Pupil-dilated; 2228 x 1652 pixels; posterior pole view; fundus photo.
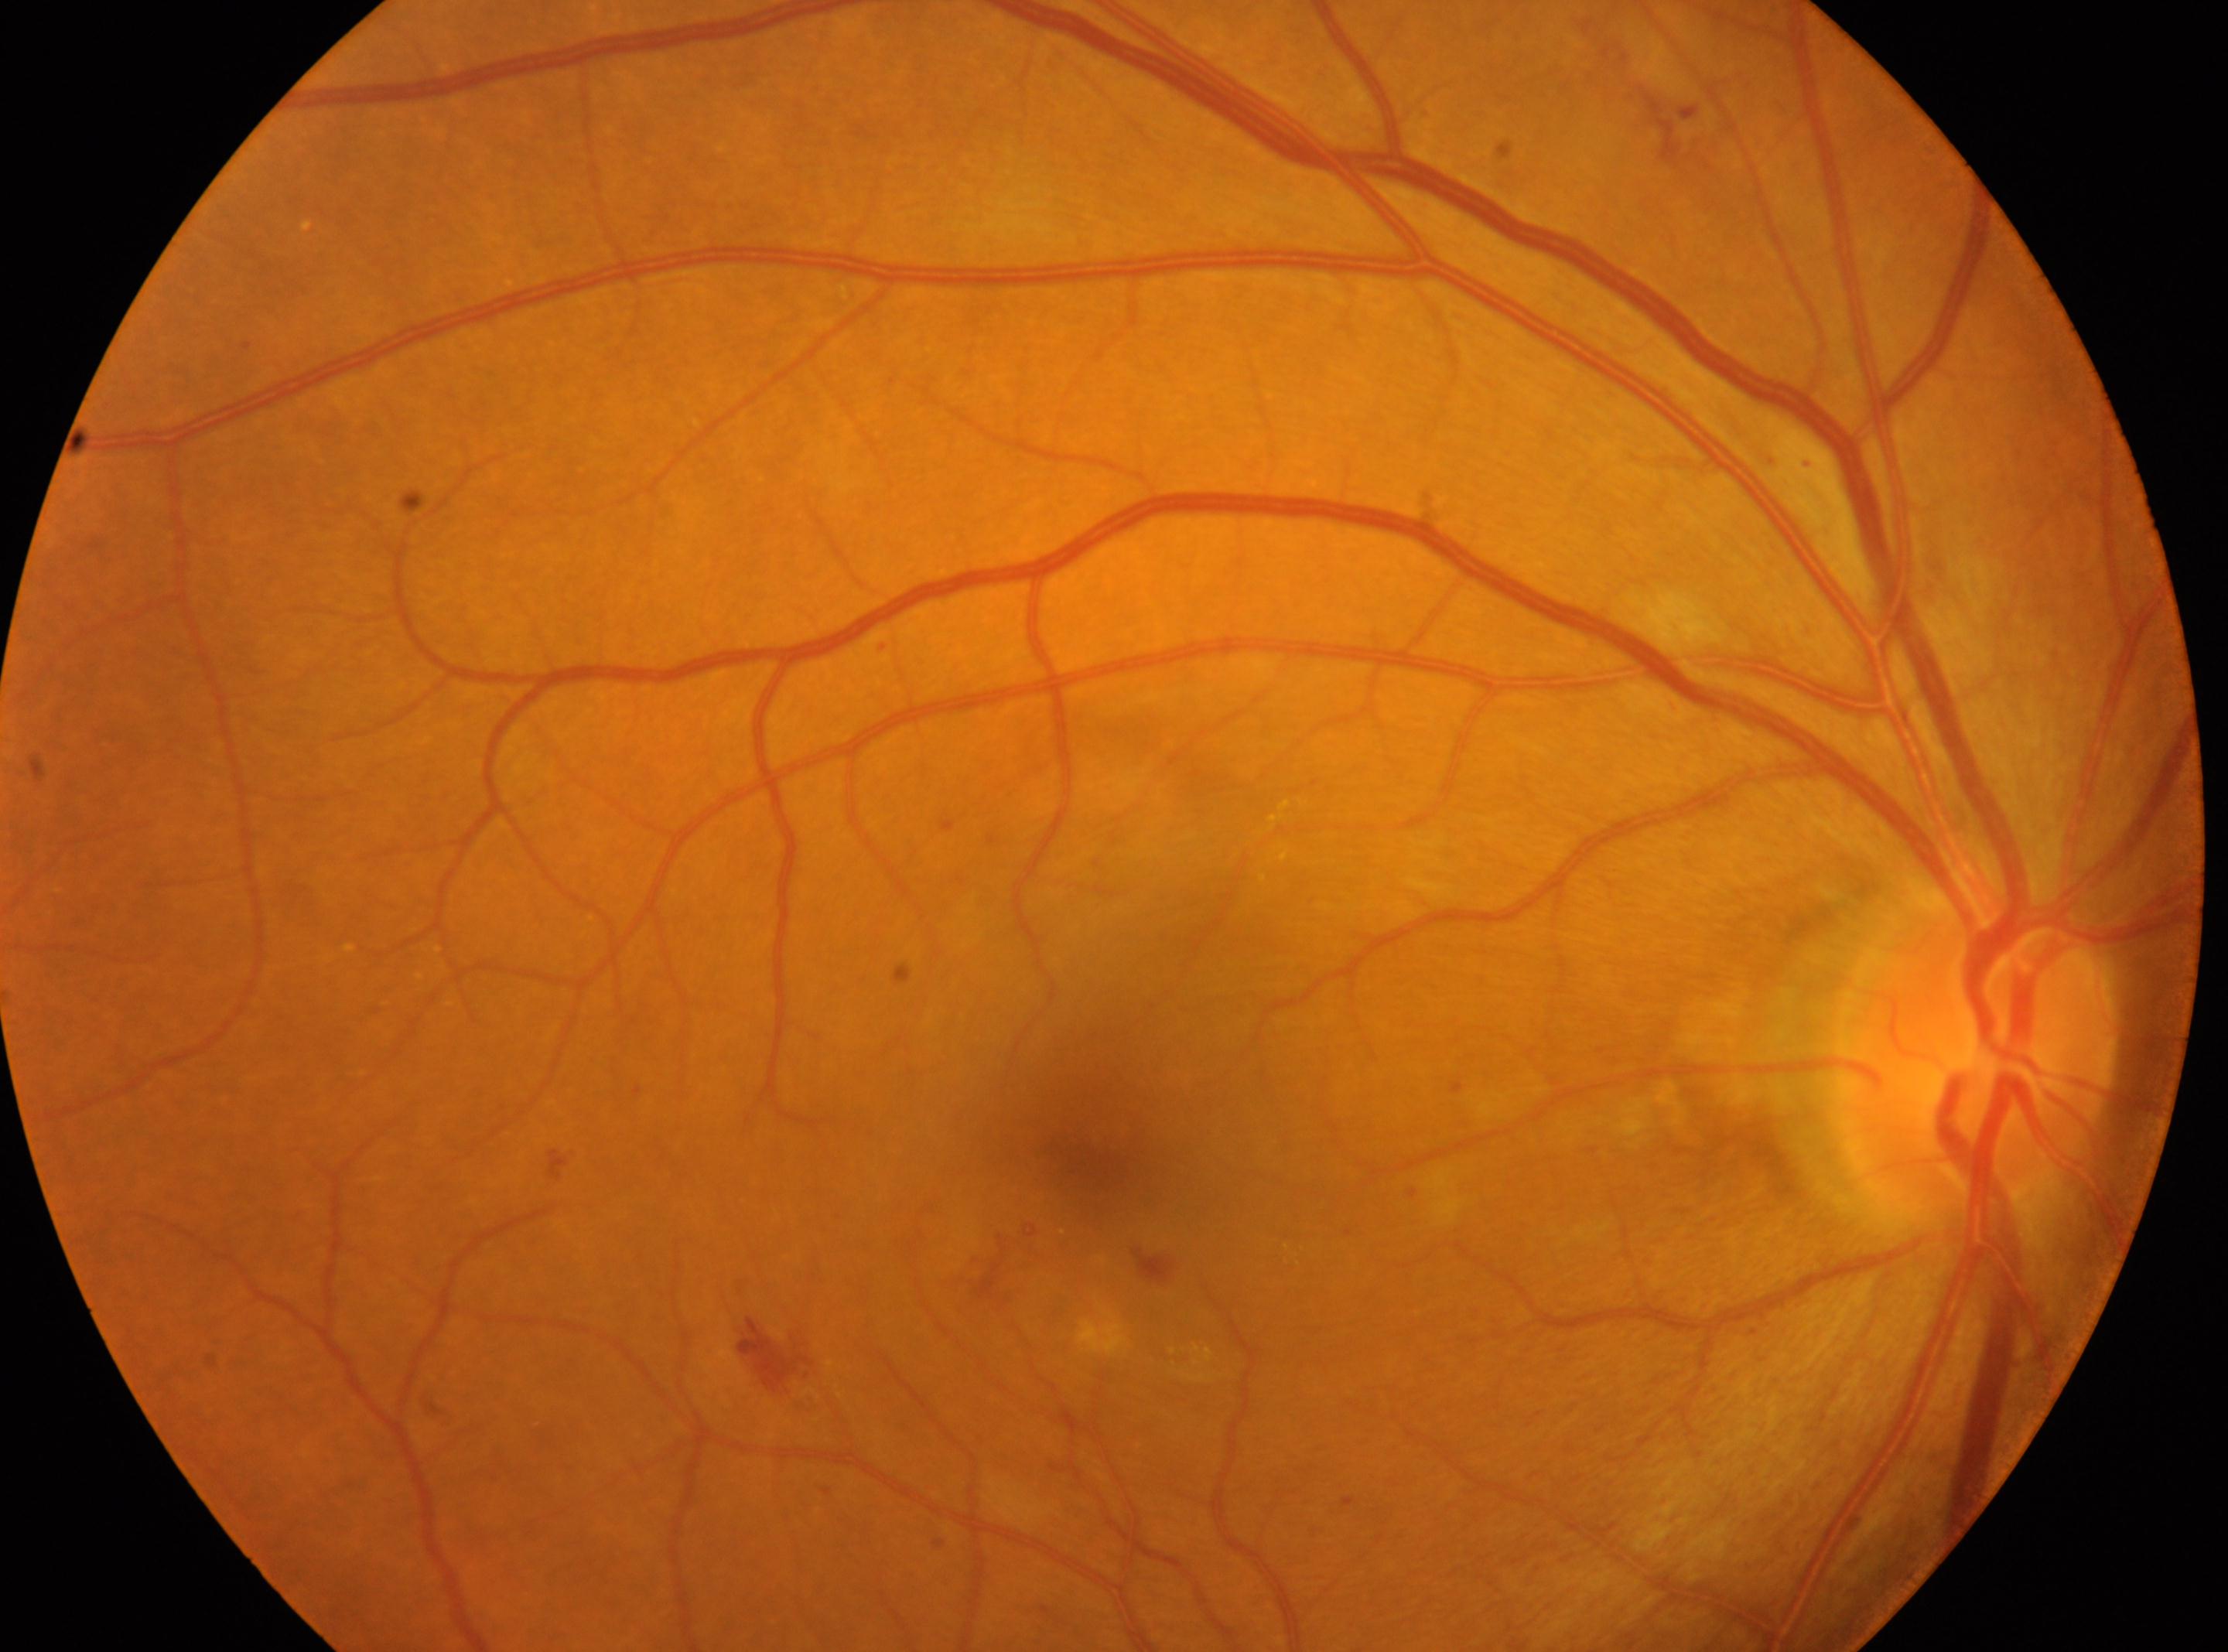

Disease class: non-proliferative diabetic retinopathy. DR stage is moderate non-proliferative diabetic retinopathy (grade 2). Optic nerve head located at (1982,1046). Eye: the right eye. The fovea centralis is at (1088,1160).